1440 by 1080 pixels; wide-field contact fundus photograph of an infant — 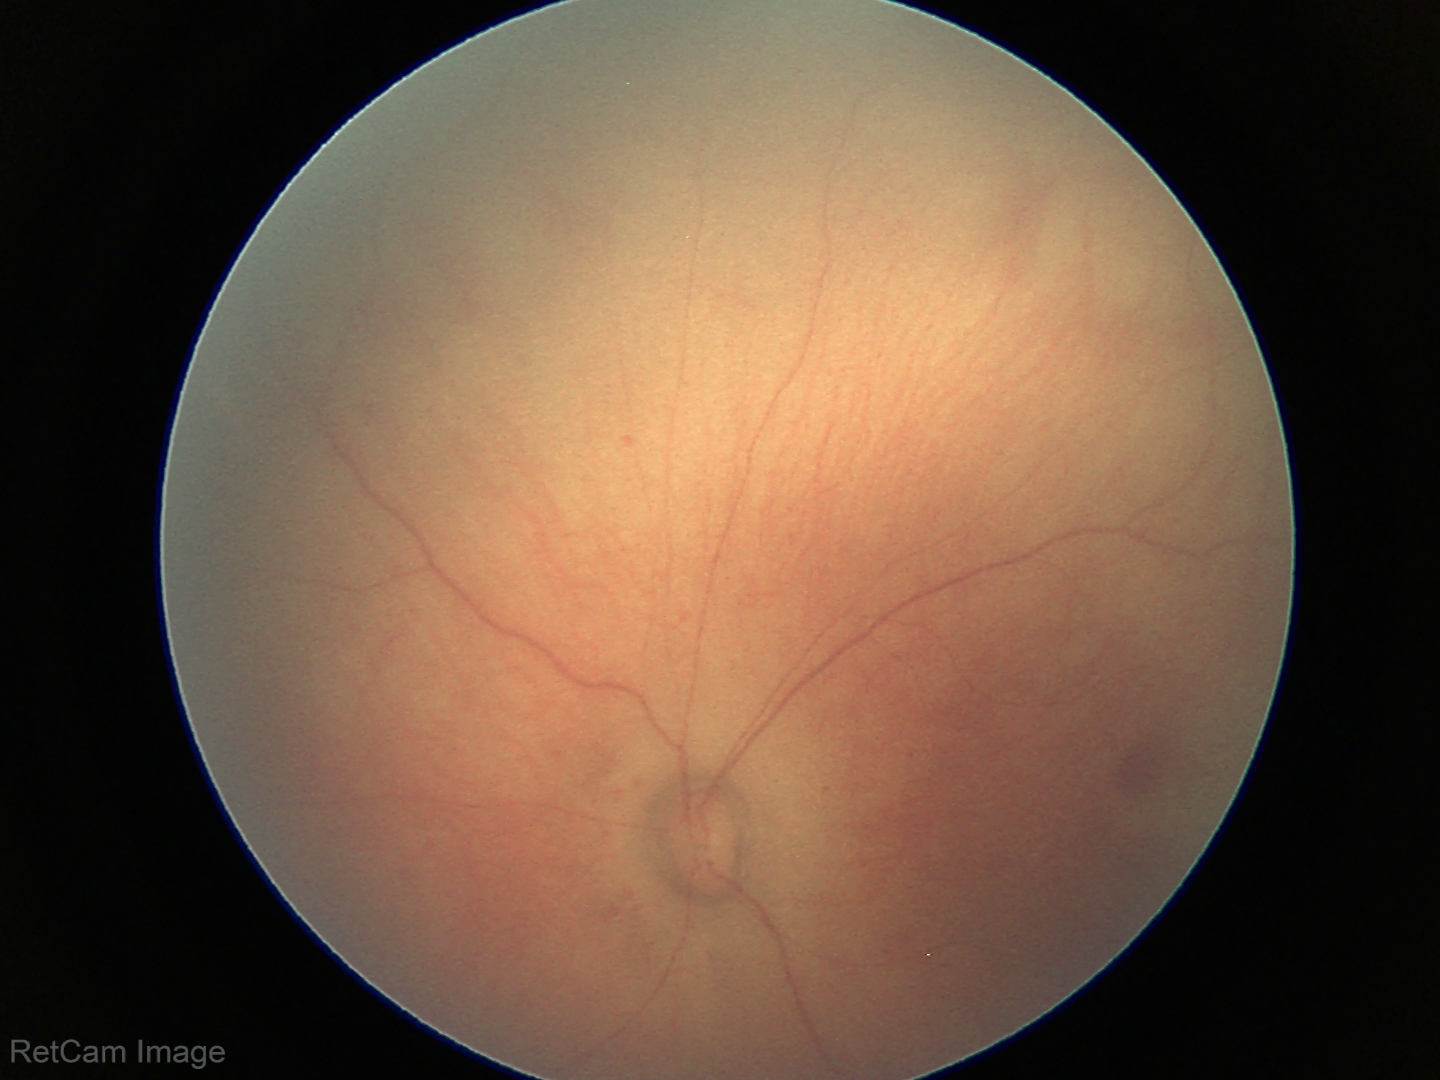
Assessment: no abnormalities.